Wide-field fundus image from infant ROP screening
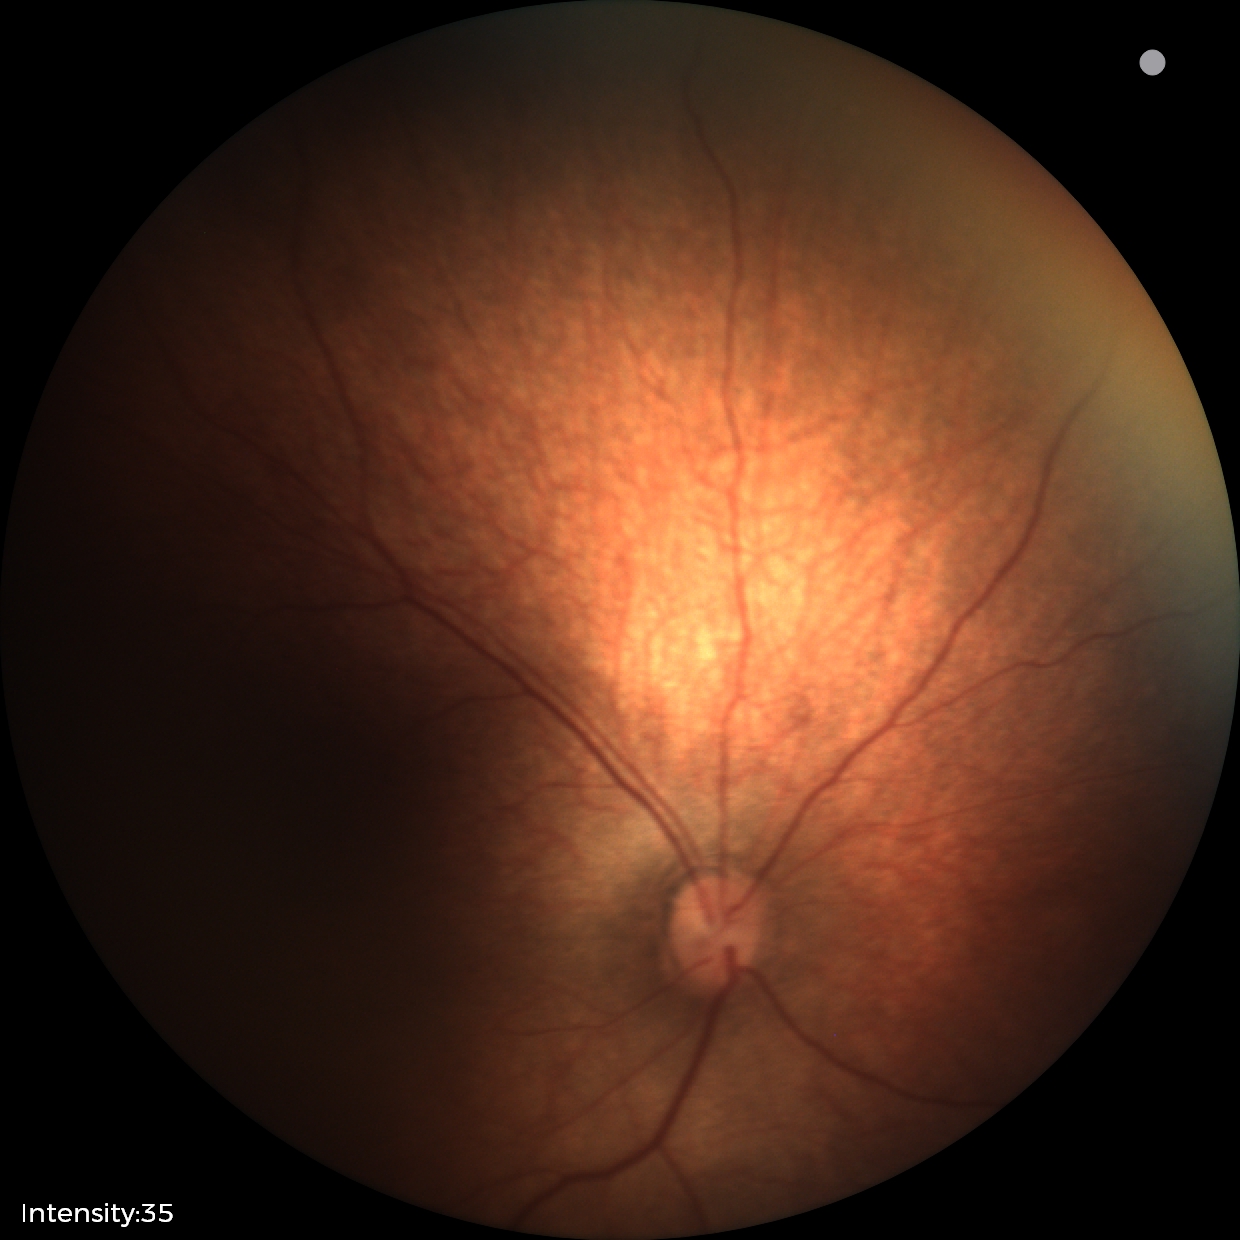 Assessment: no pathology identified.